45° FOV; image size 1932x1932.
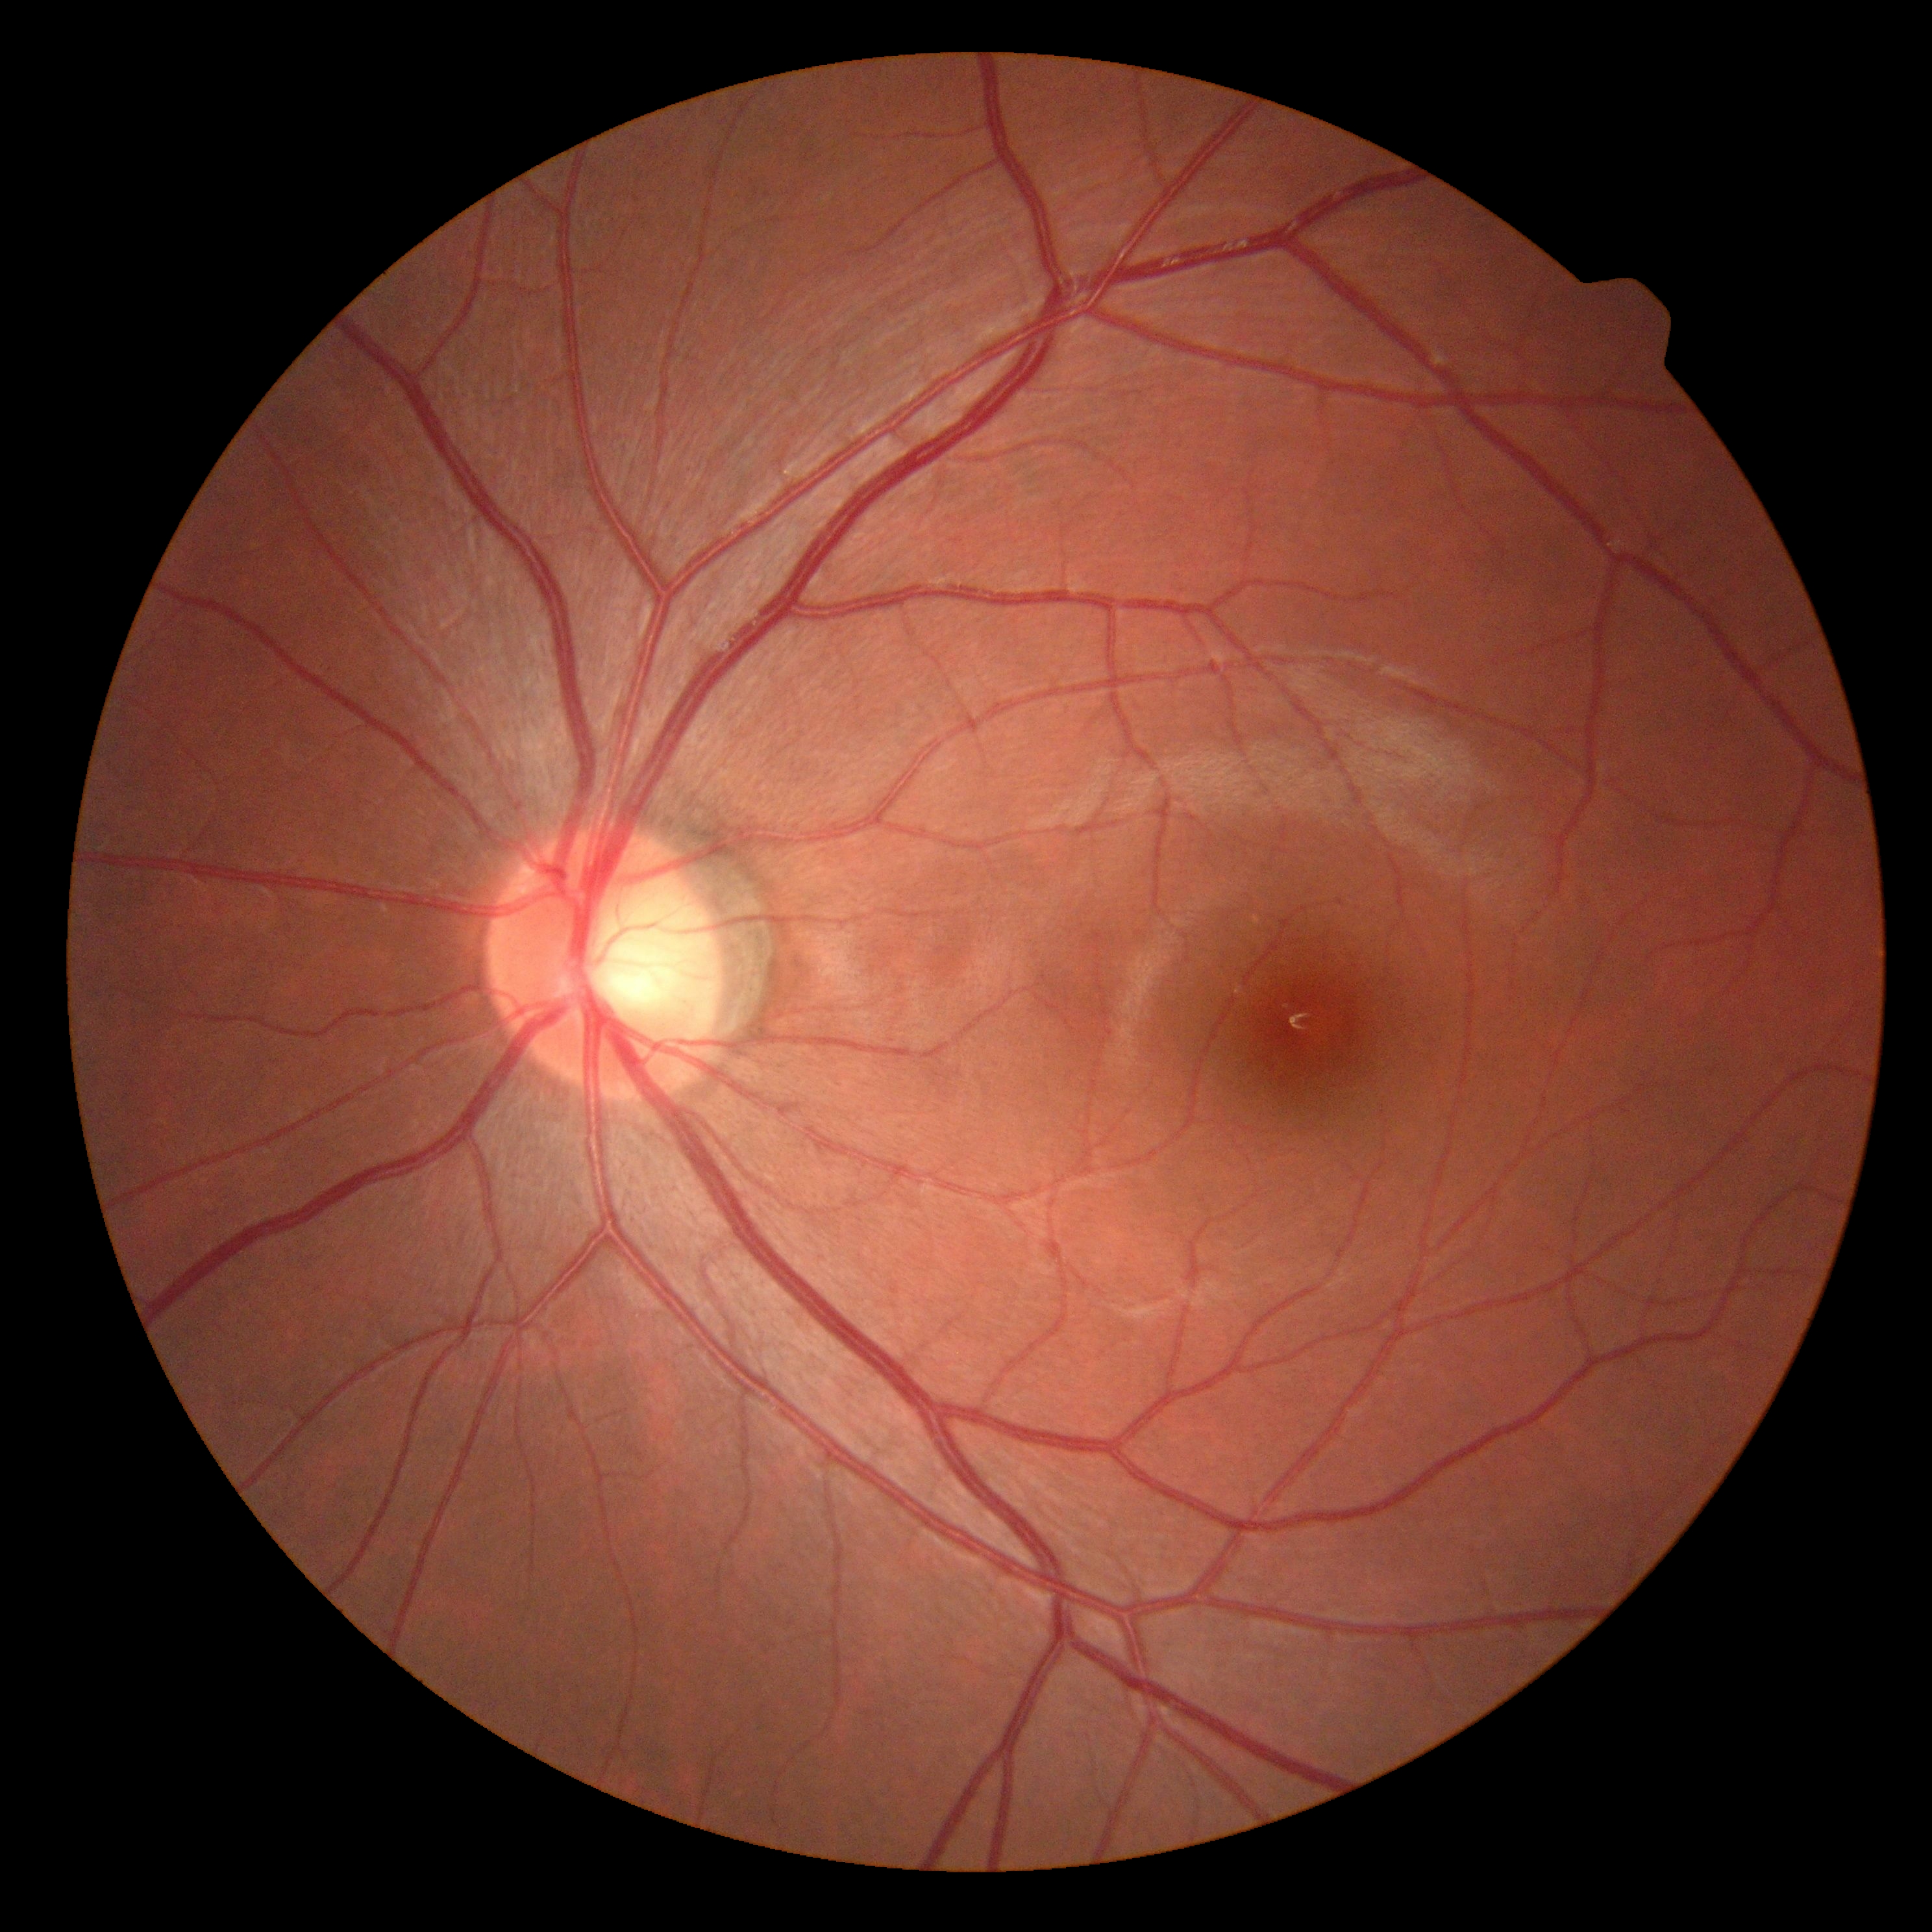
dr_grade: 0/4